Color fundus photograph: 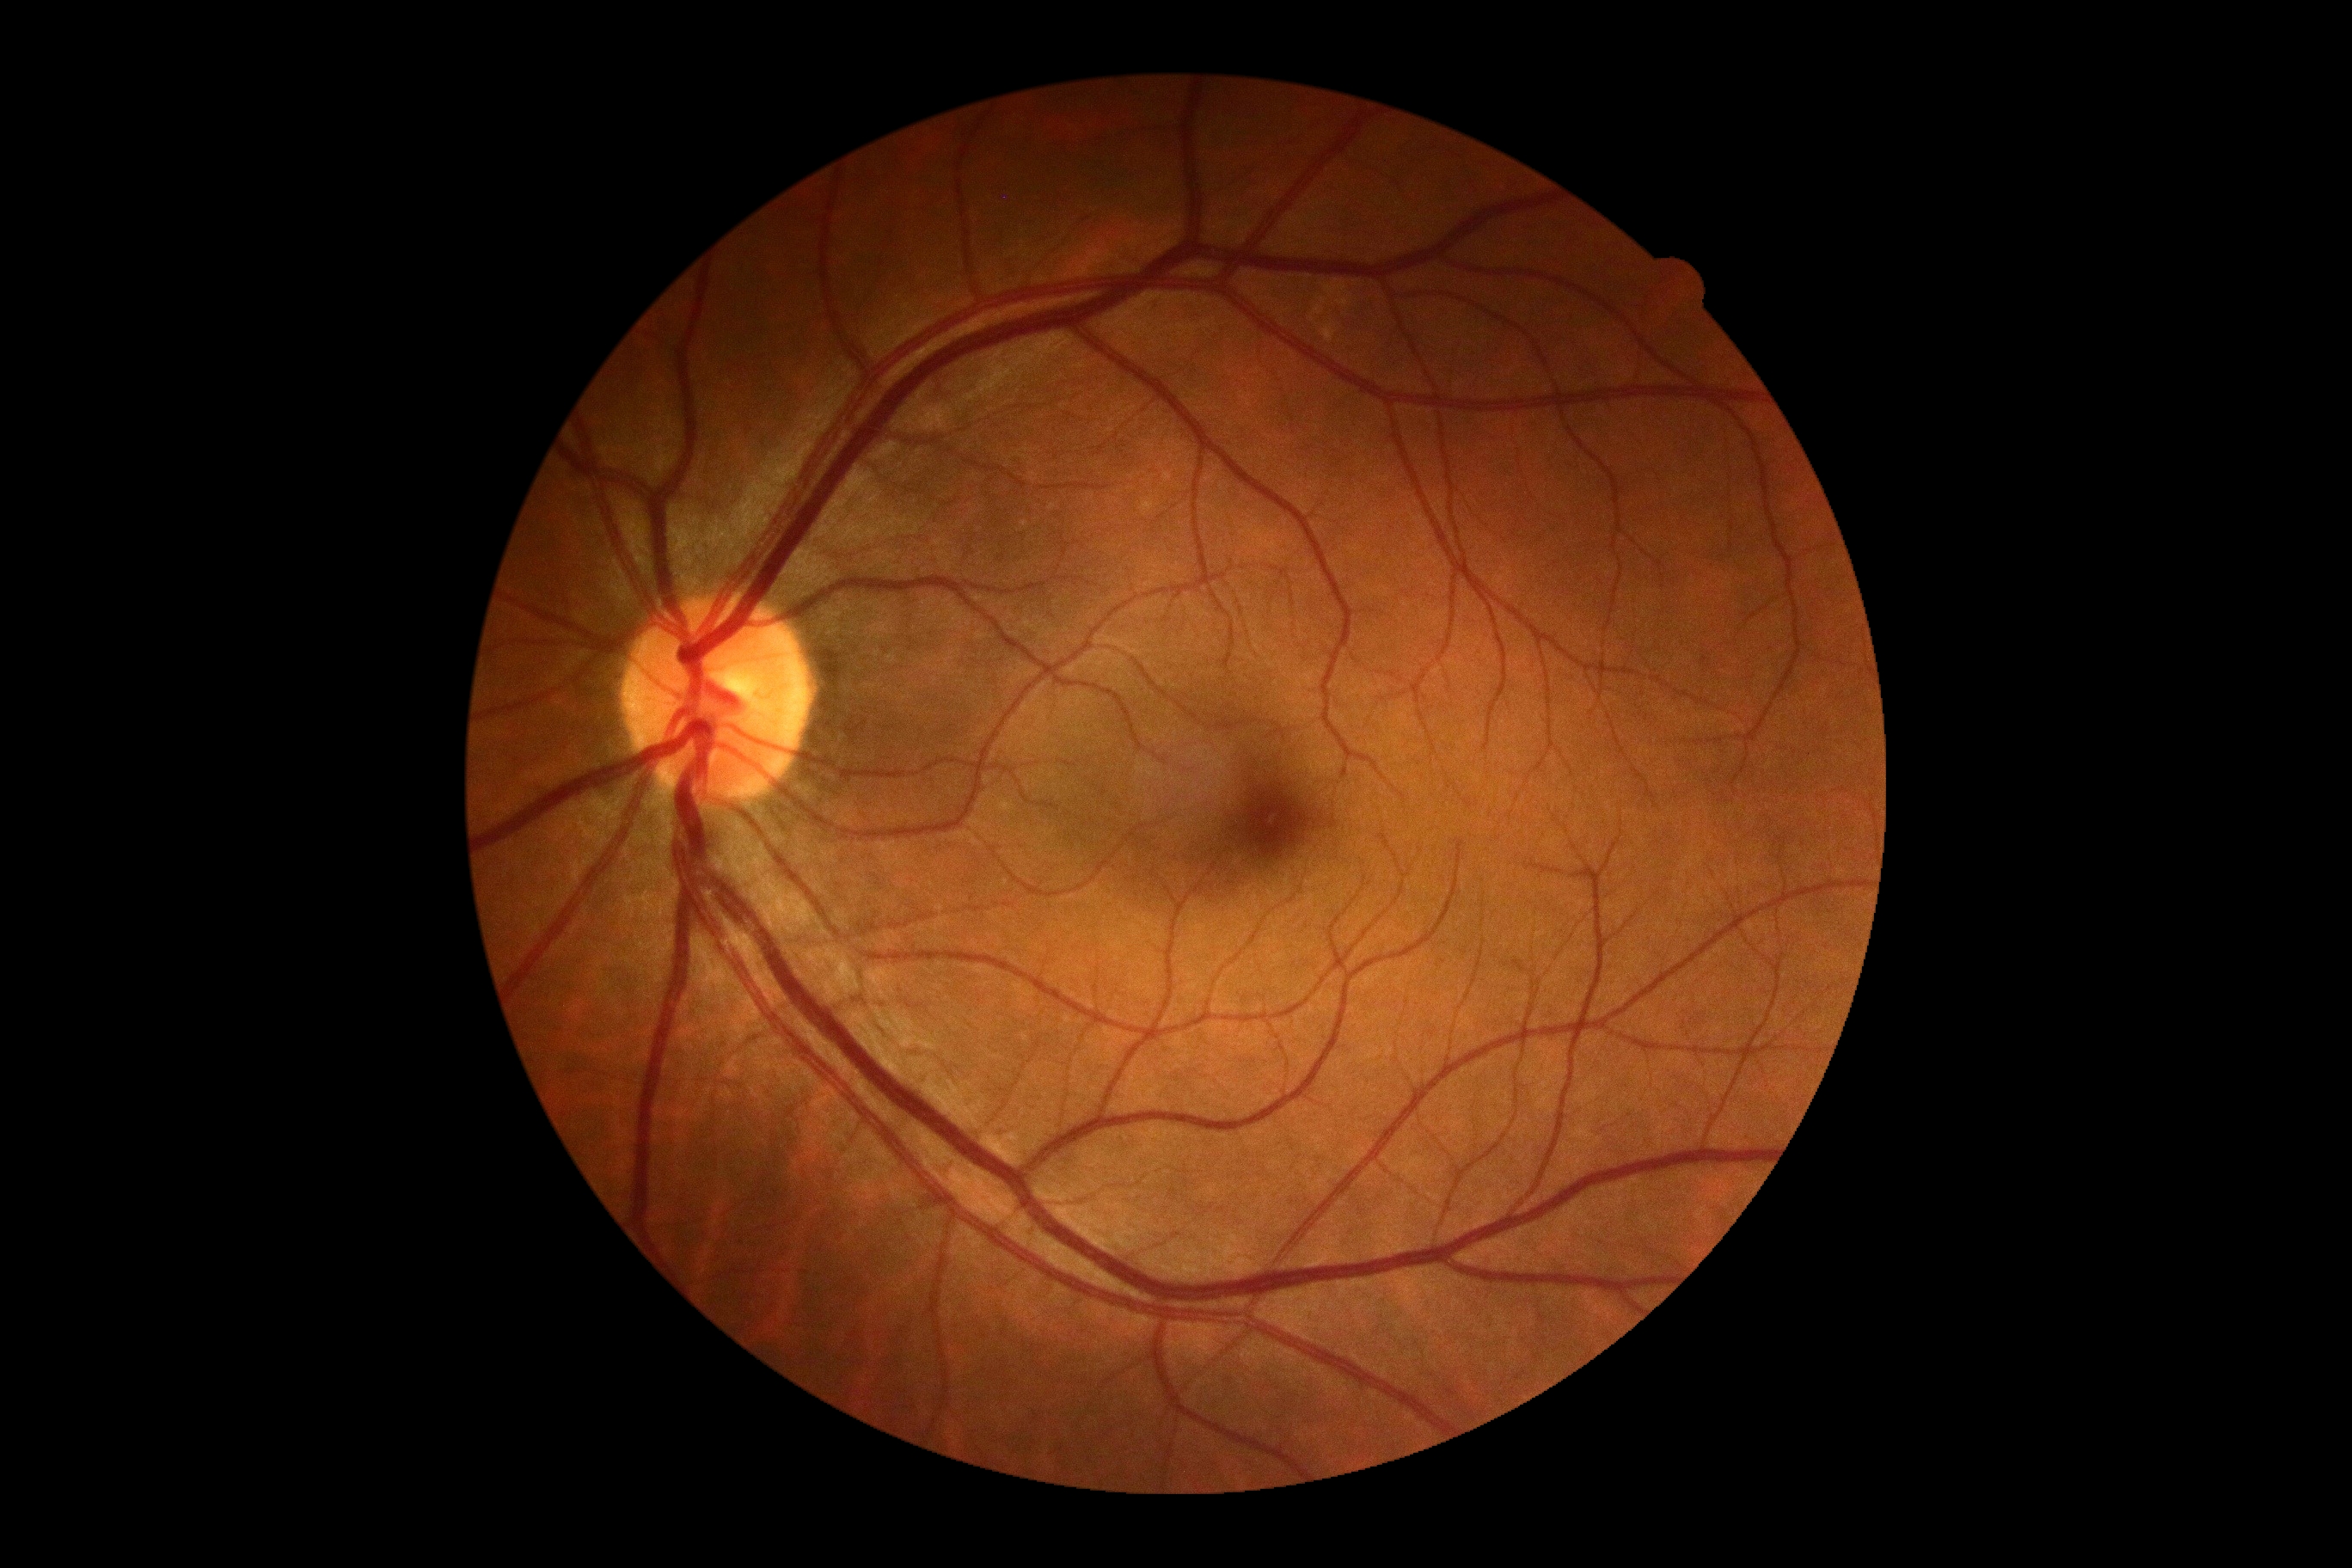 No DR findings. Retinopathy grade: no apparent retinopathy (0).